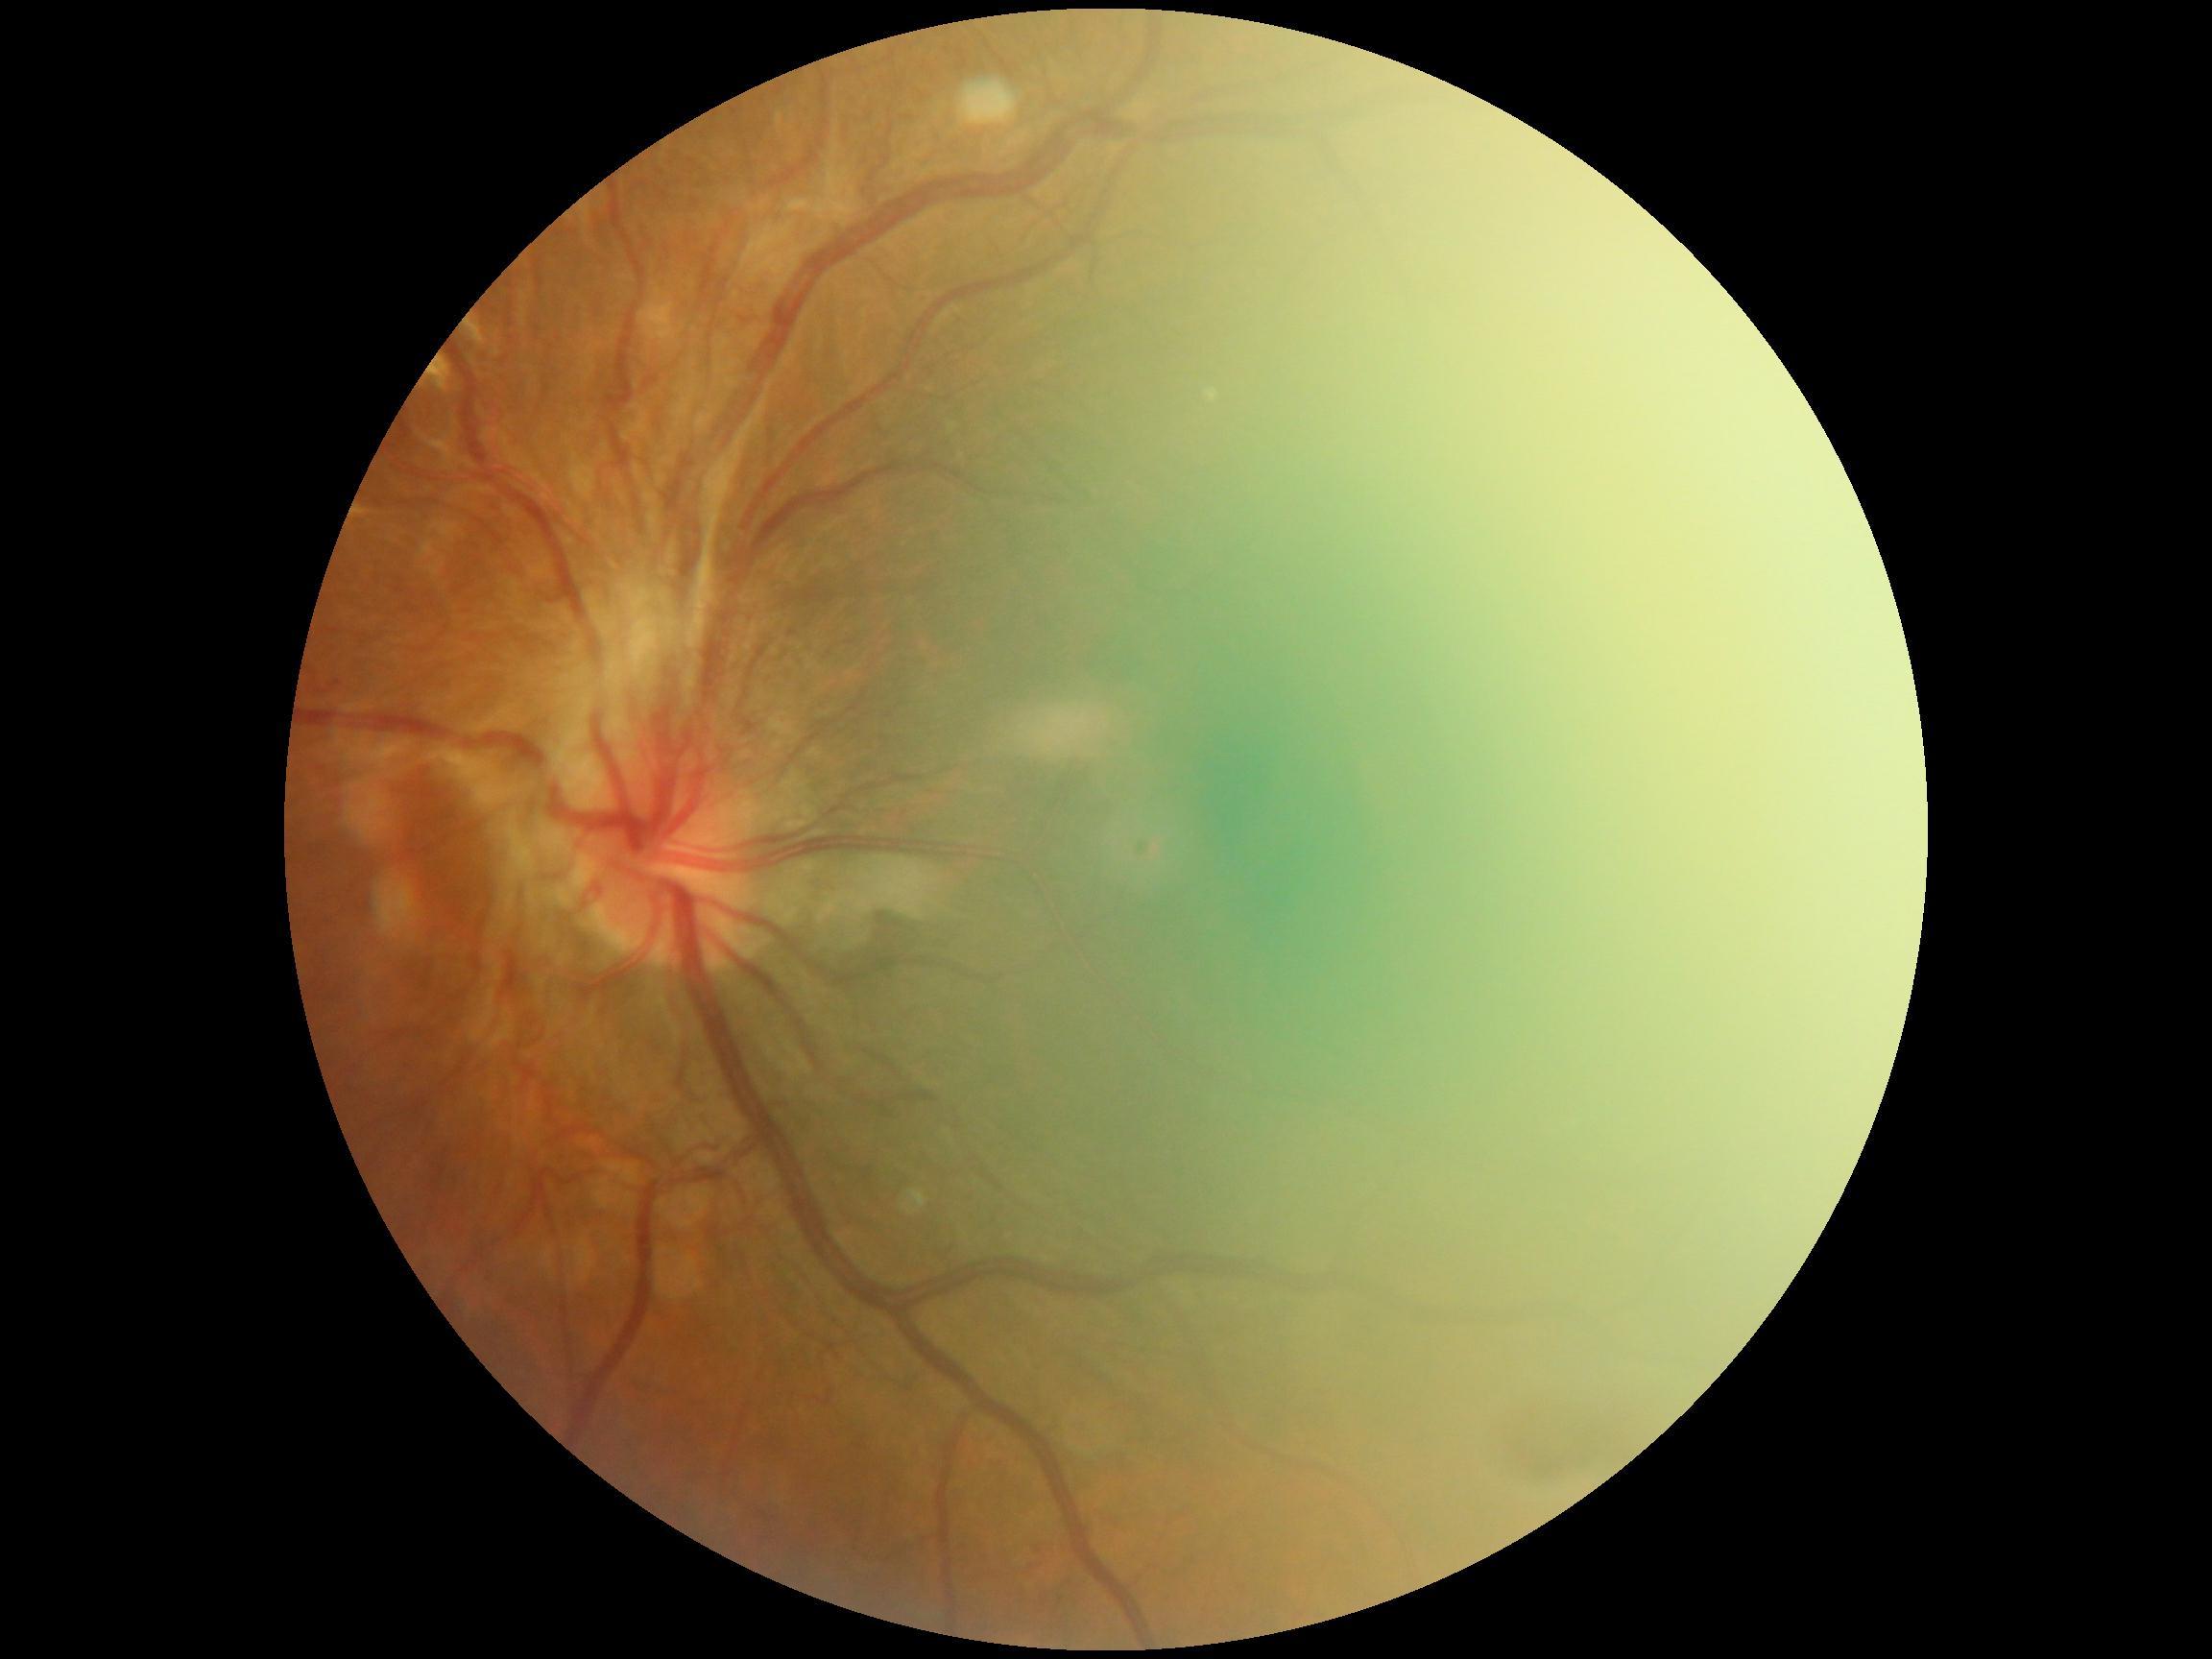

{
  "dr_grade": "grade 4 (PDR)",
  "dr_category": "proliferative diabetic retinopathy"
}